45° field of view. Image size 2352x1568. Retinal fundus photograph — 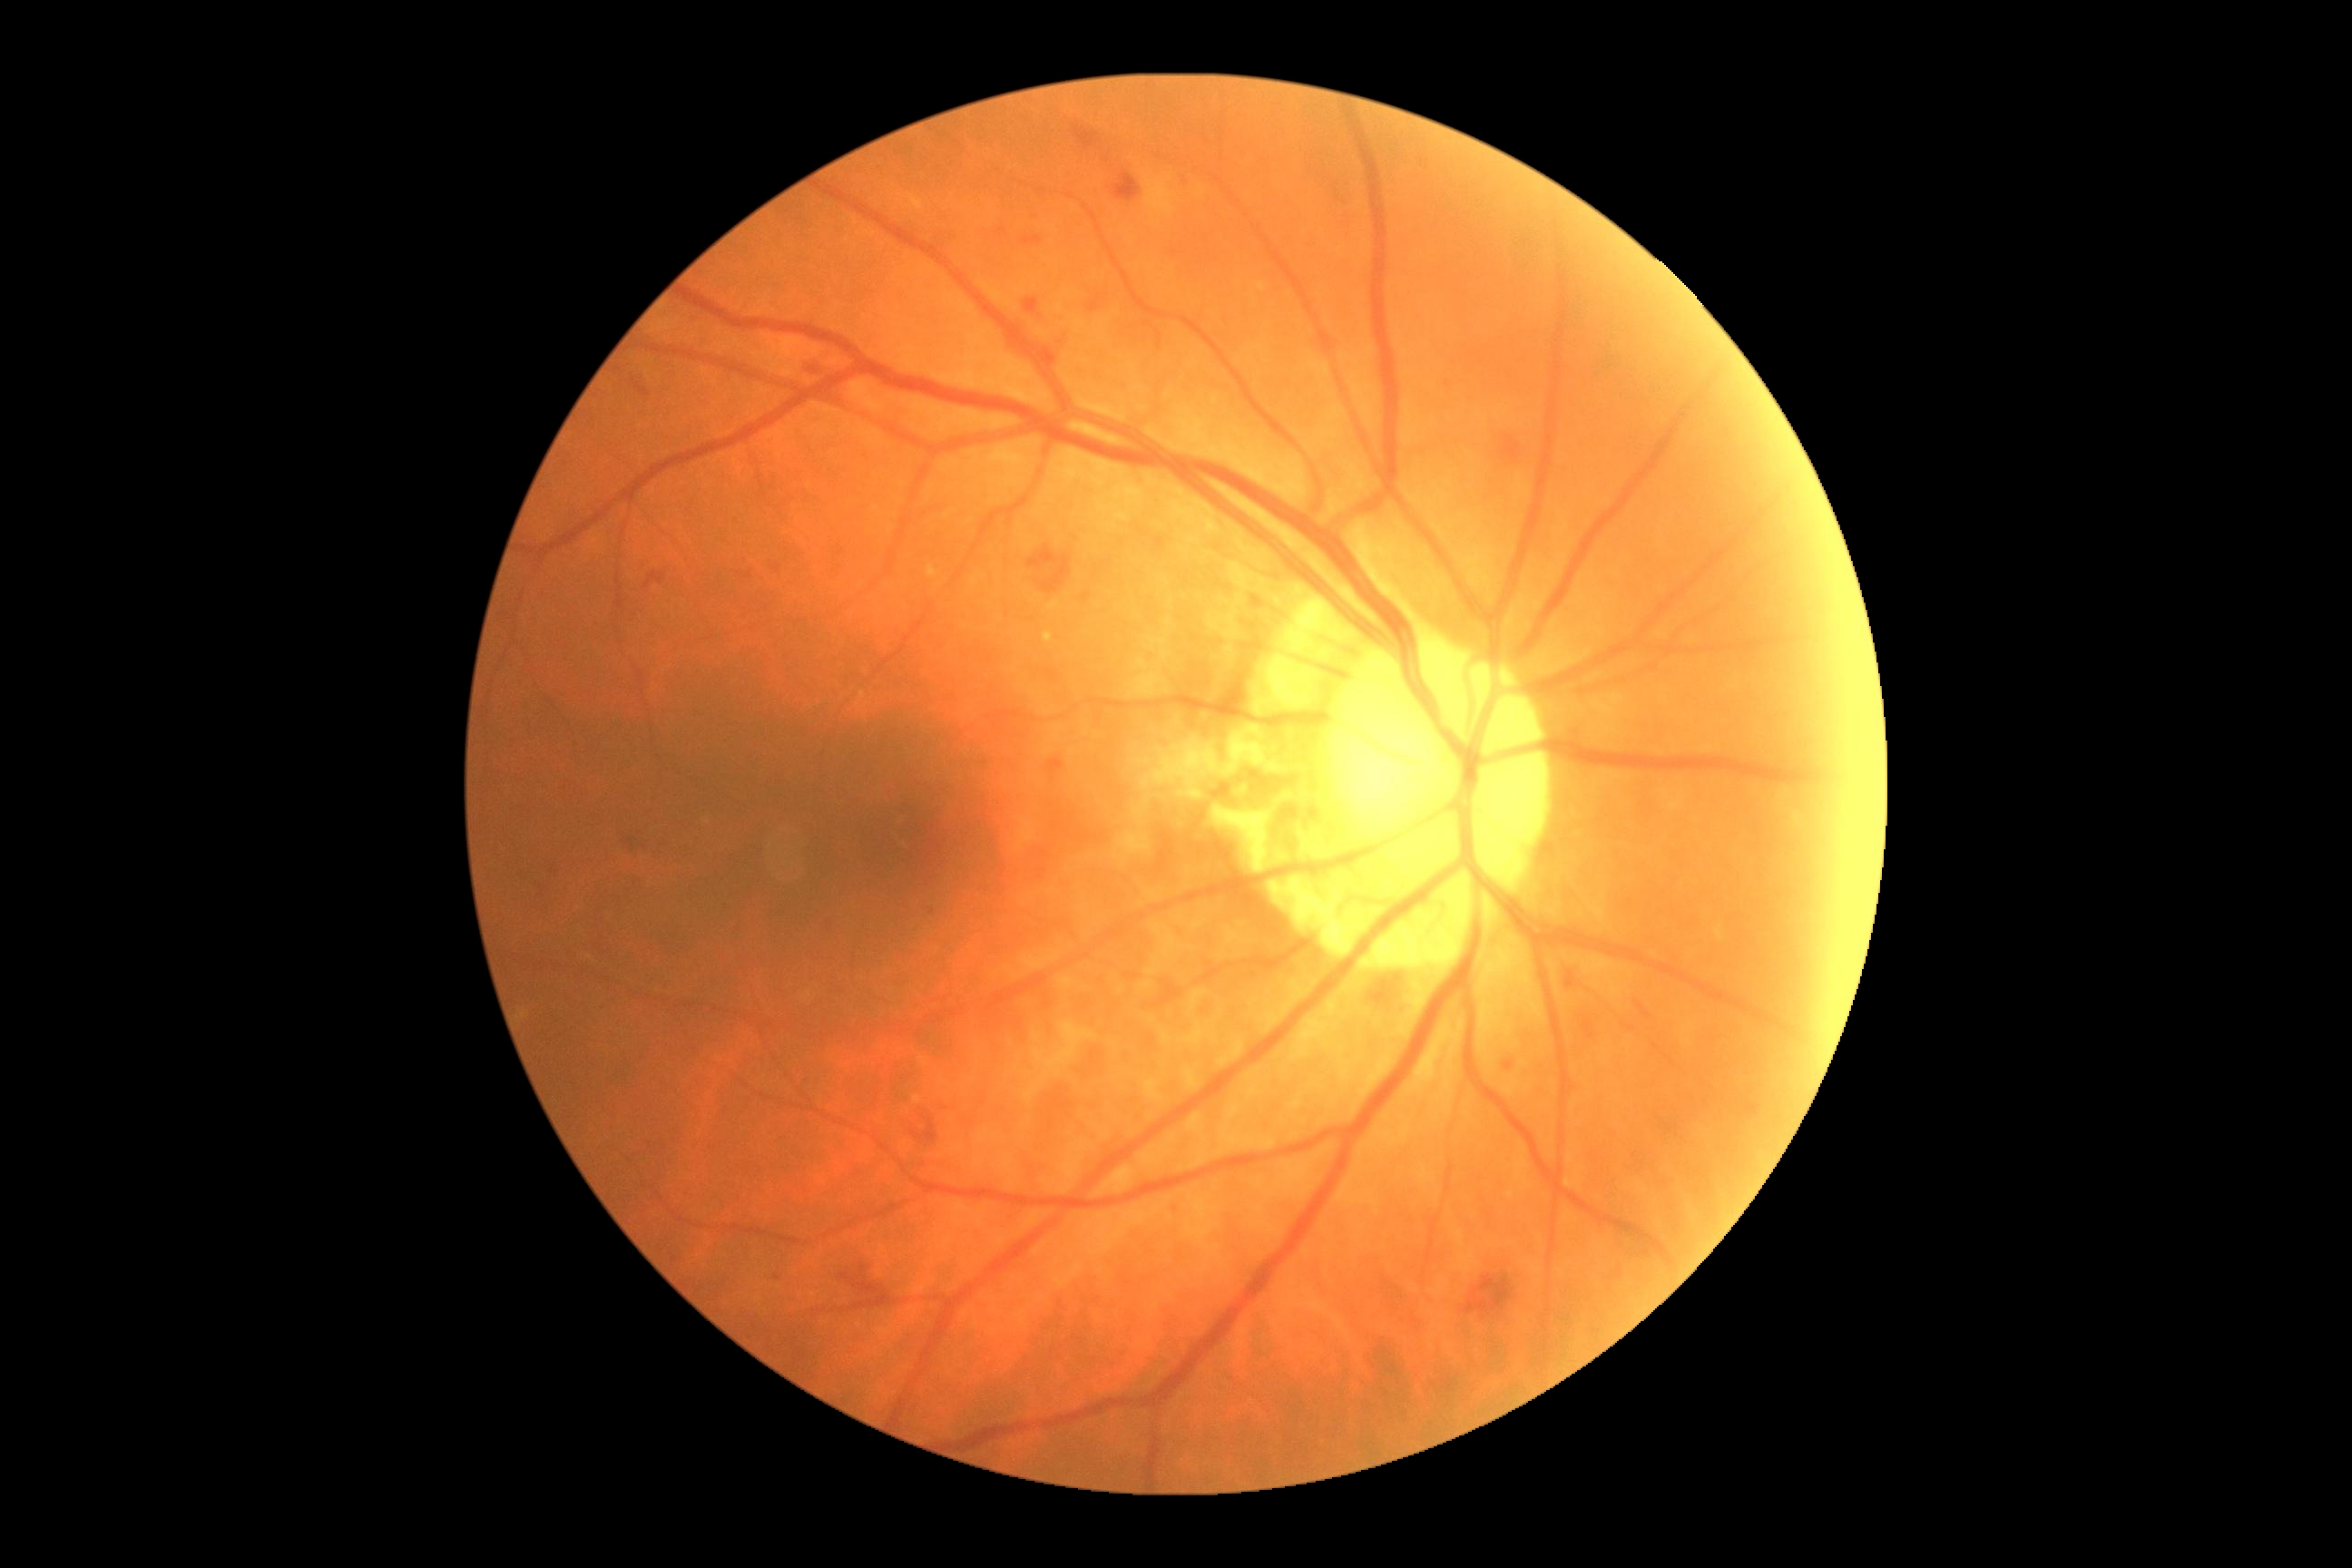 DR stage is grade 2 (moderate NPDR)
Lesions identified (partial list):
- EXs (continued): 928 565 939 578; 1043 632 1054 643
- MAs: none detected
- SEs: none detected
- HEs (continued): 803 348 848 382; 921 500 946 527; 1745 1104 1758 1115; 1088 297 1101 313; 734 565 758 583; 1021 237 1043 246; 1500 436 1522 460; 1112 172 1141 202; 821 917 834 932; 1046 758 1064 776; 1416 309 1429 322; 839 1260 890 1302; 1462 1240 1533 1322; 1155 538 1164 549; 1026 540 1088 598
- Small HEs approximately at x=1001 y=232; x=777 y=1277